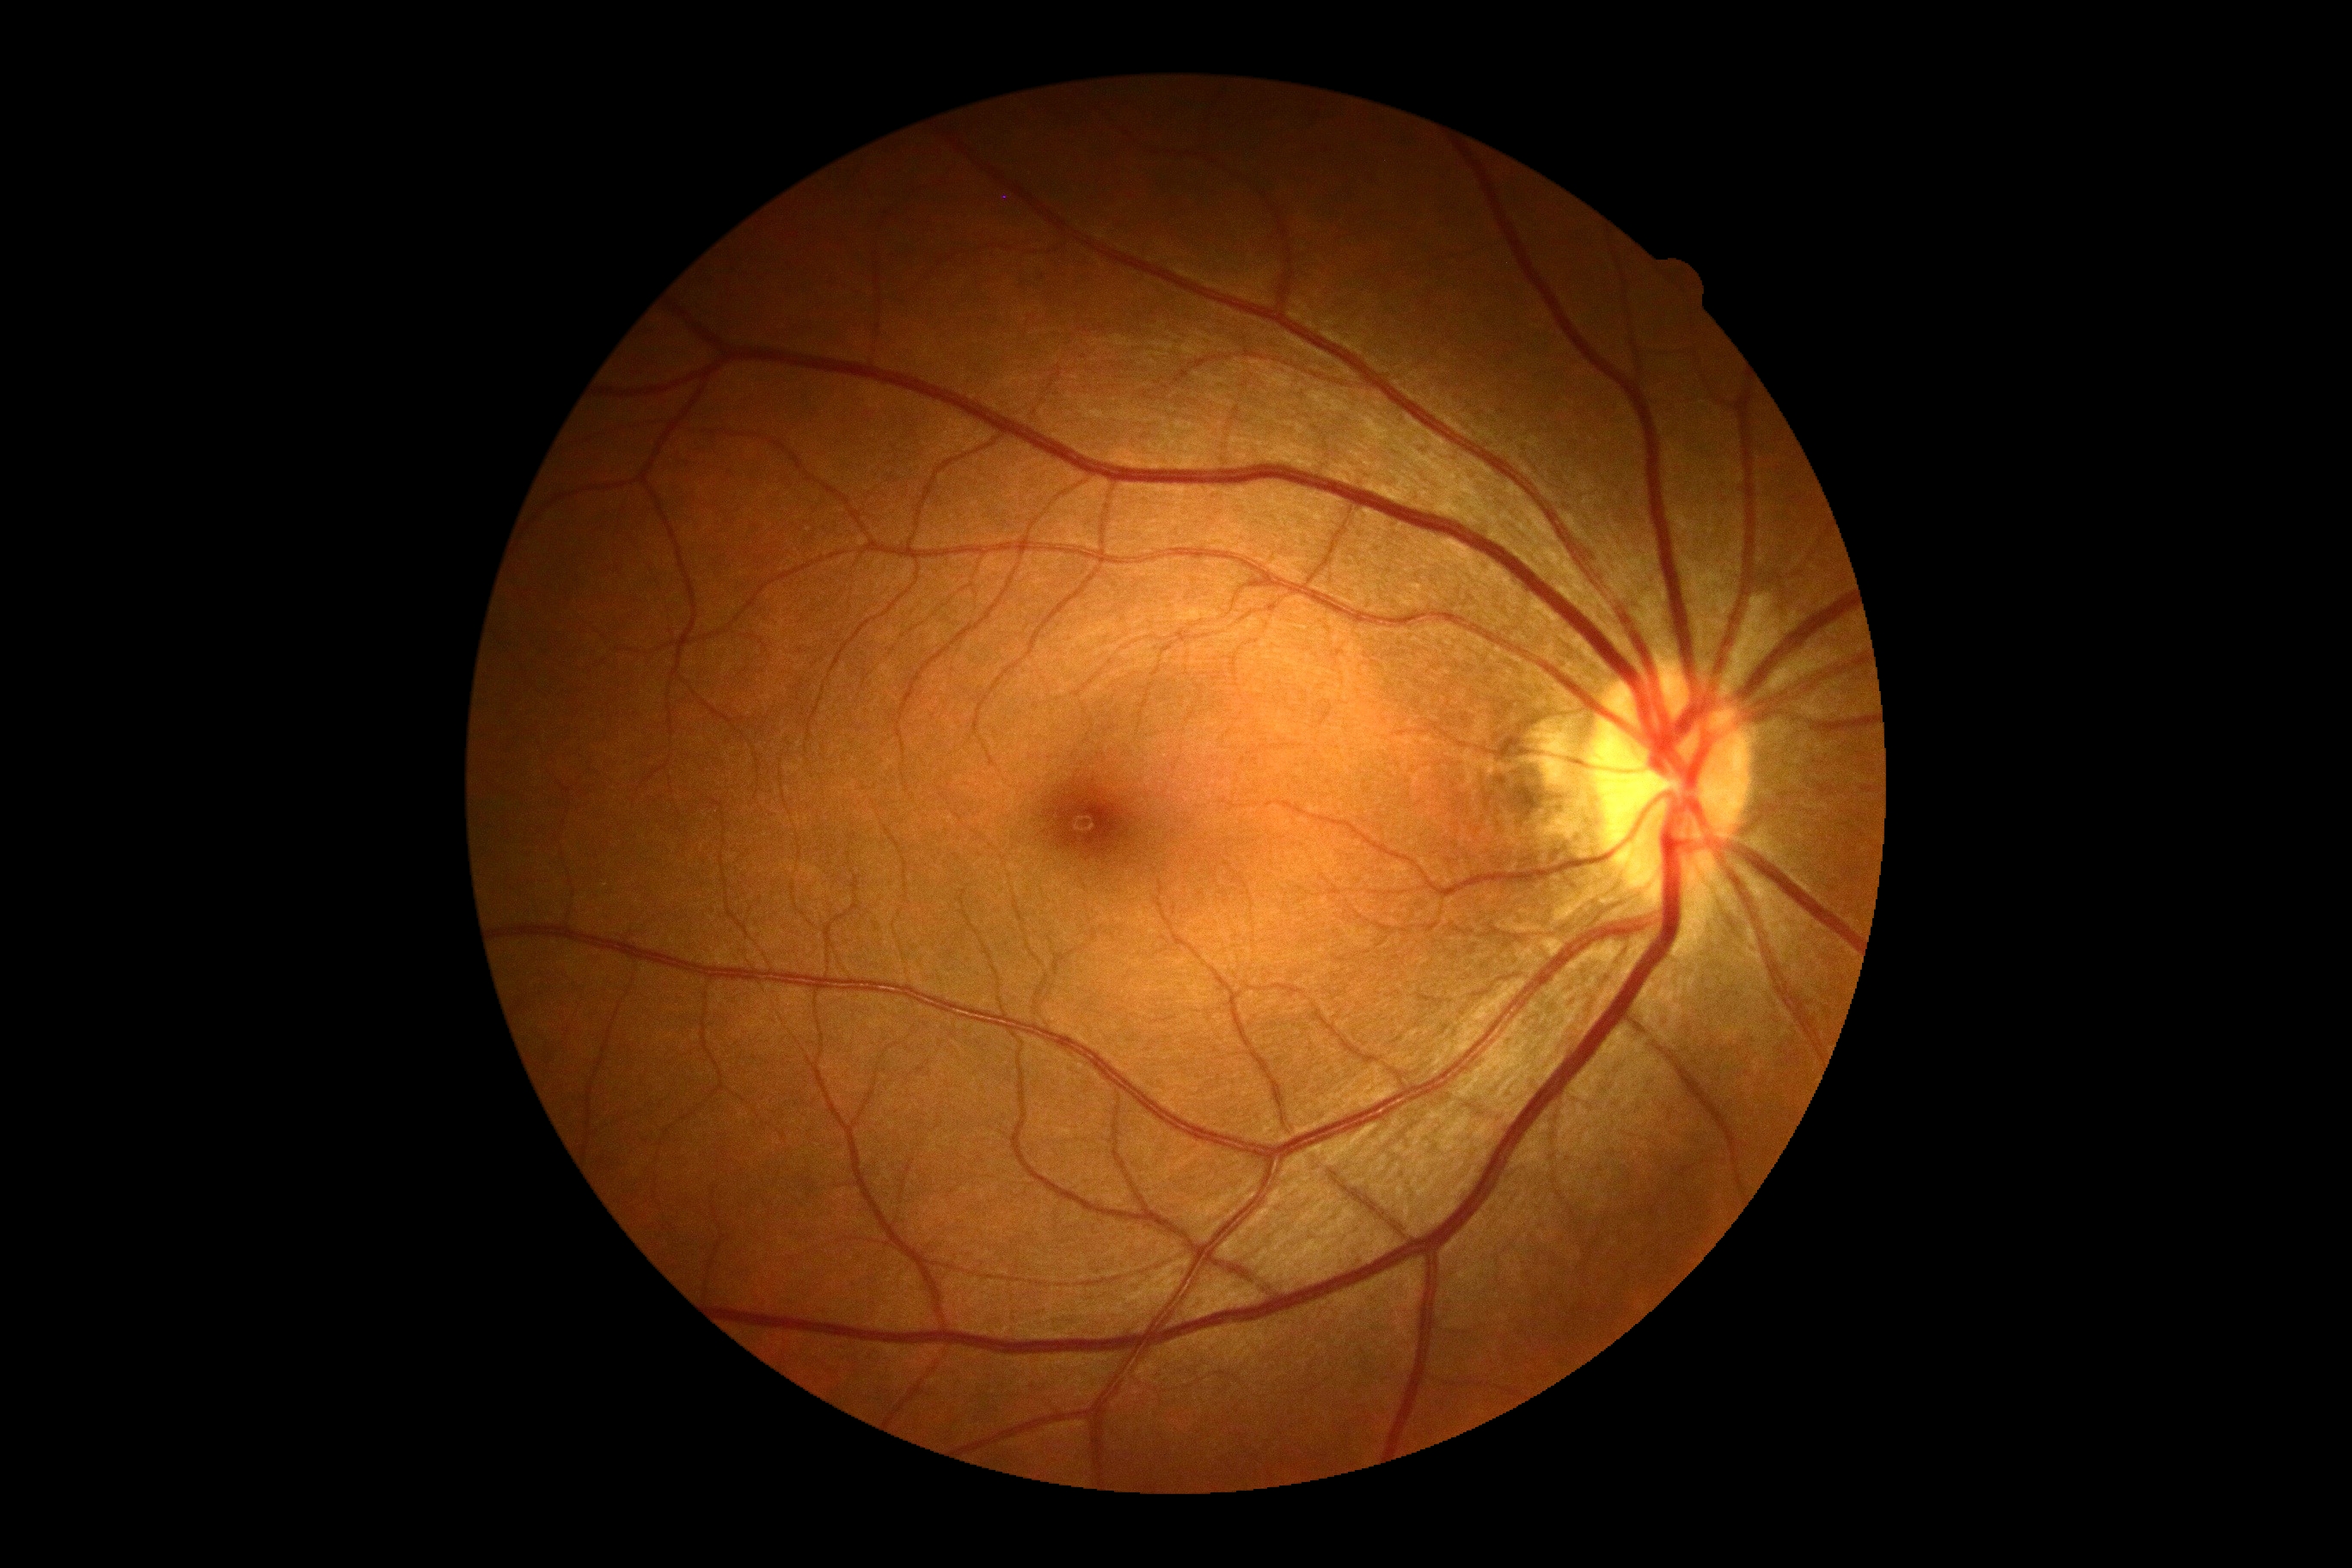

DR grade is 0/4. No DR findings.